640 x 480 pixels · camera: Clarity RetCam 3 (130° FOV) · infant wide-field fundus photograph — 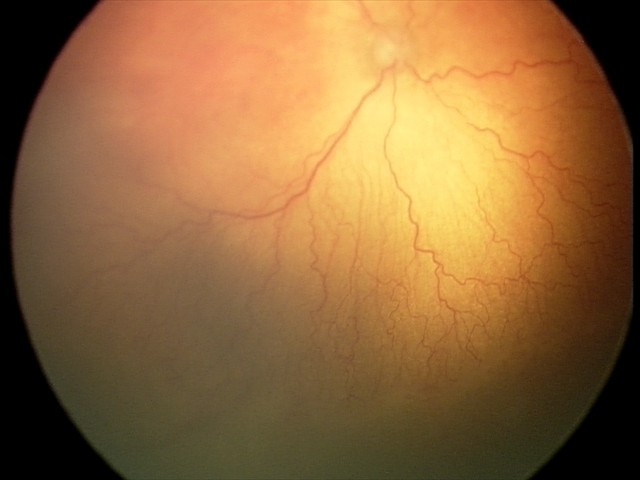
With plus disease.
Screening examination consistent with aggressive retinopathy of prematurity (A-ROP) — rapidly progressive severe ROP with prominent plus disease, often without classic stage progression.